Wide-field fundus photograph of an infant:
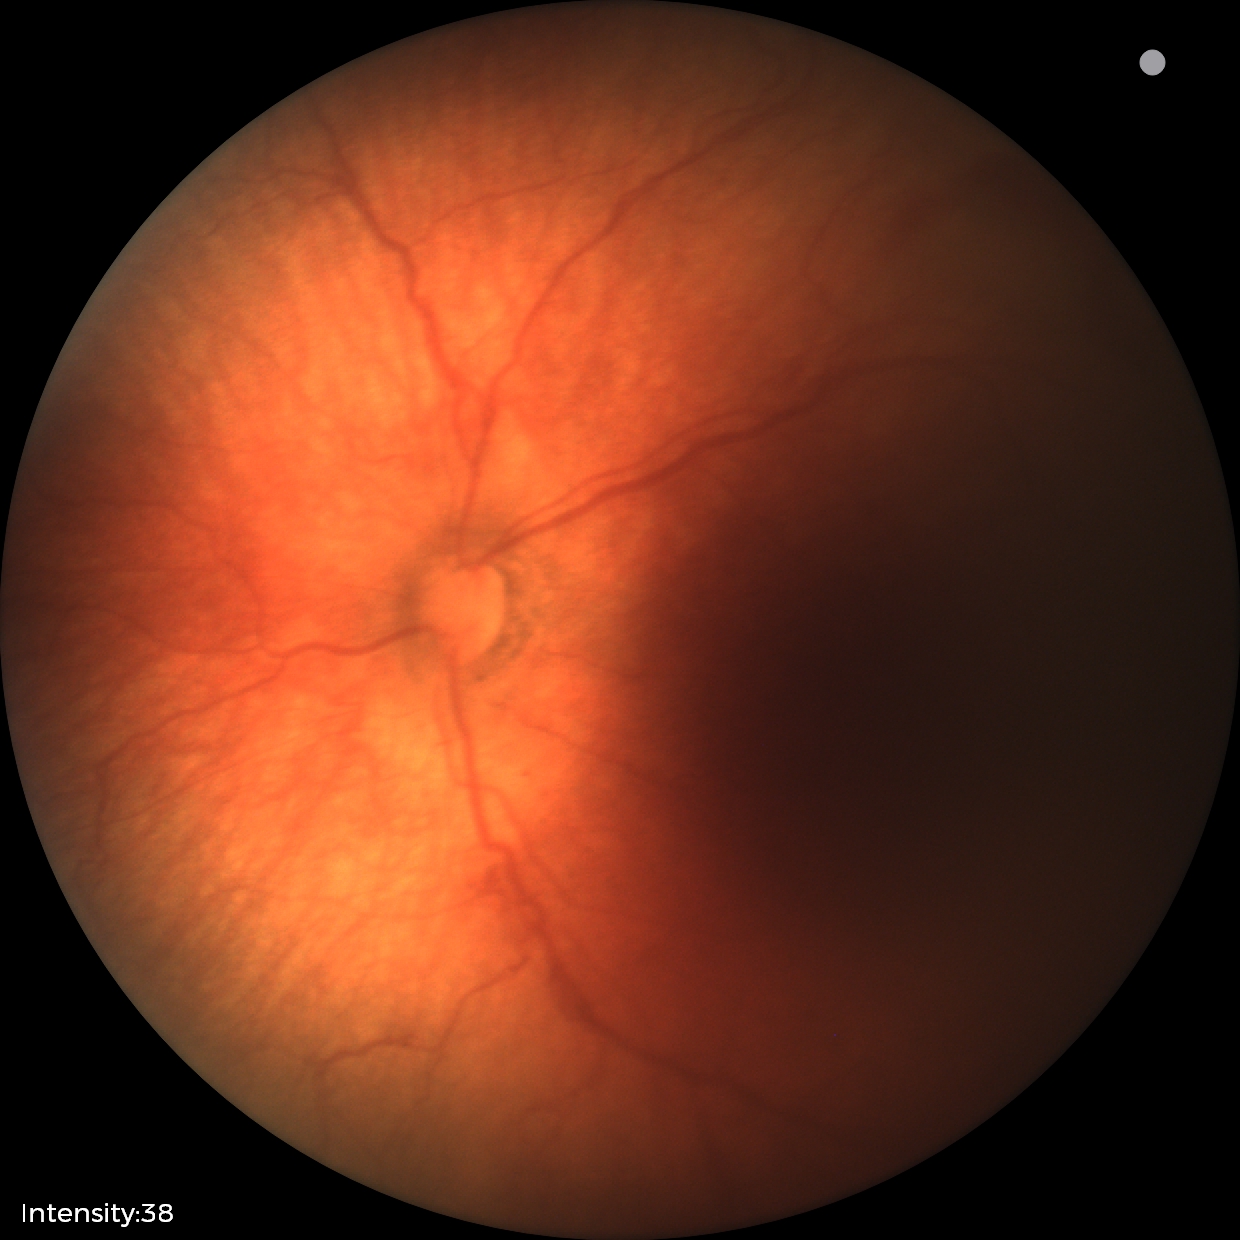

Screening examination consistent with status post retinopathy of prematurity (ROP). Plus disease absent.